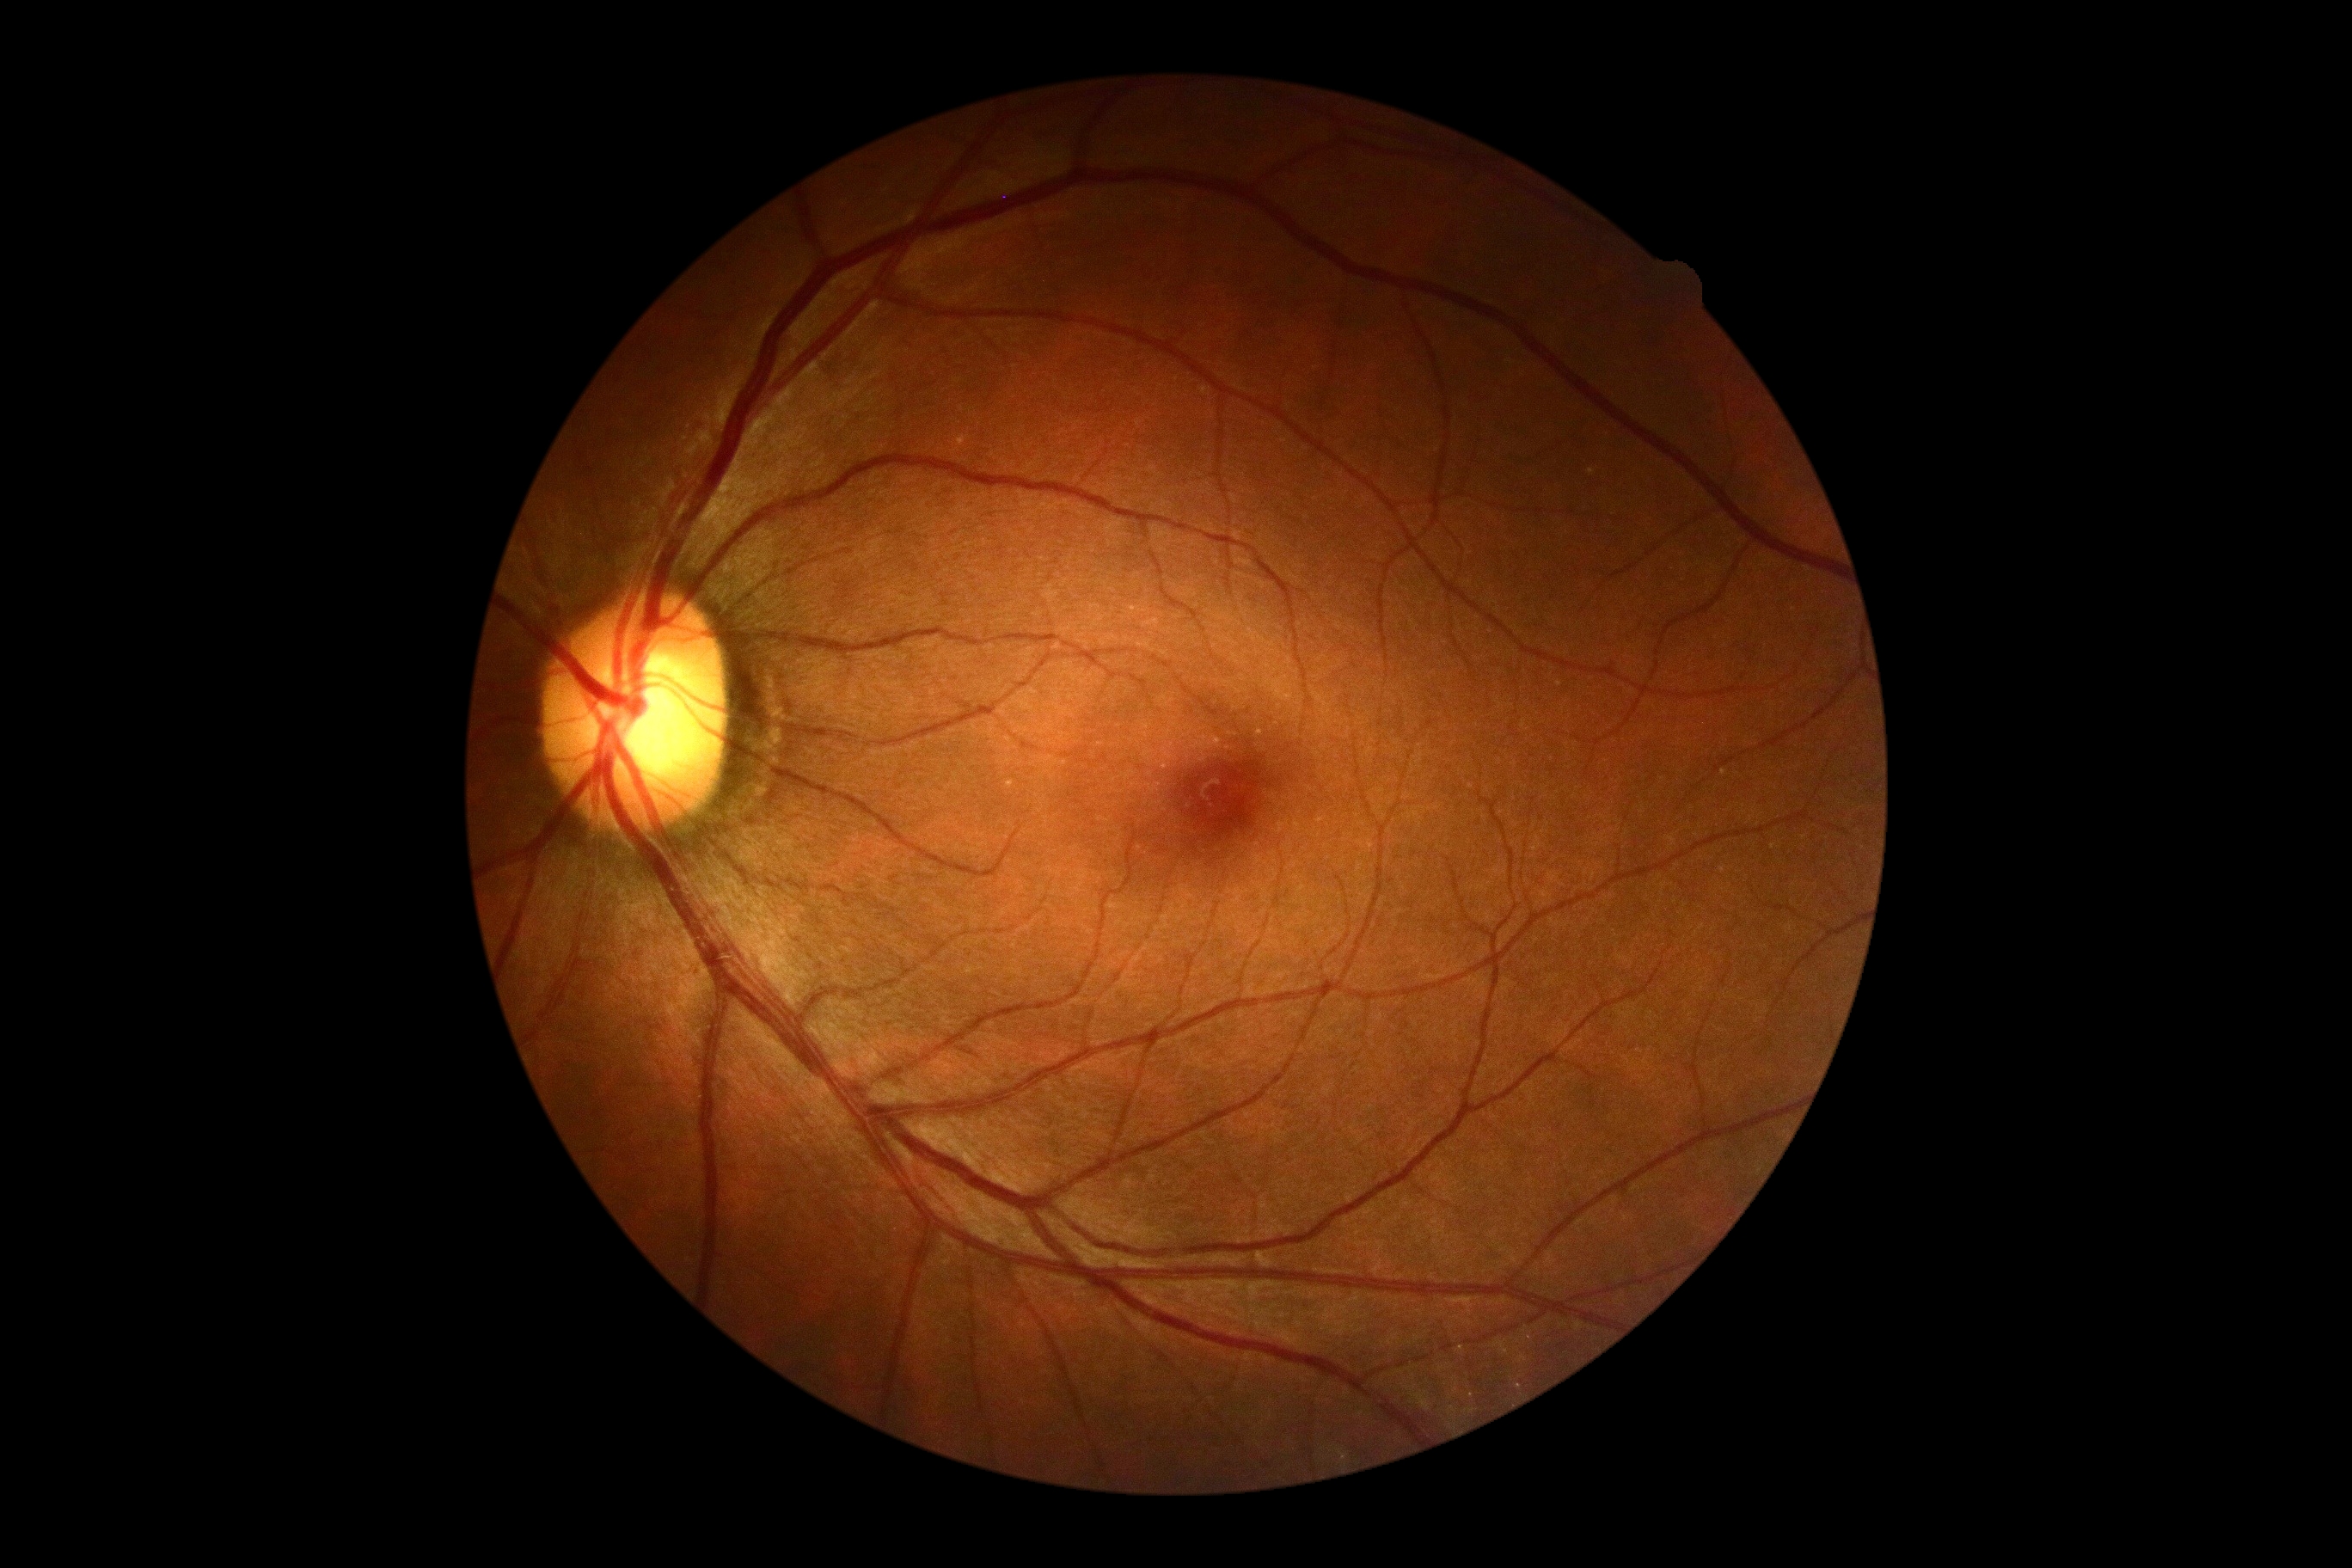 DR impression = no DR findings
retinopathy grade = no apparent retinopathy (0) — no visible signs of diabetic retinopathy